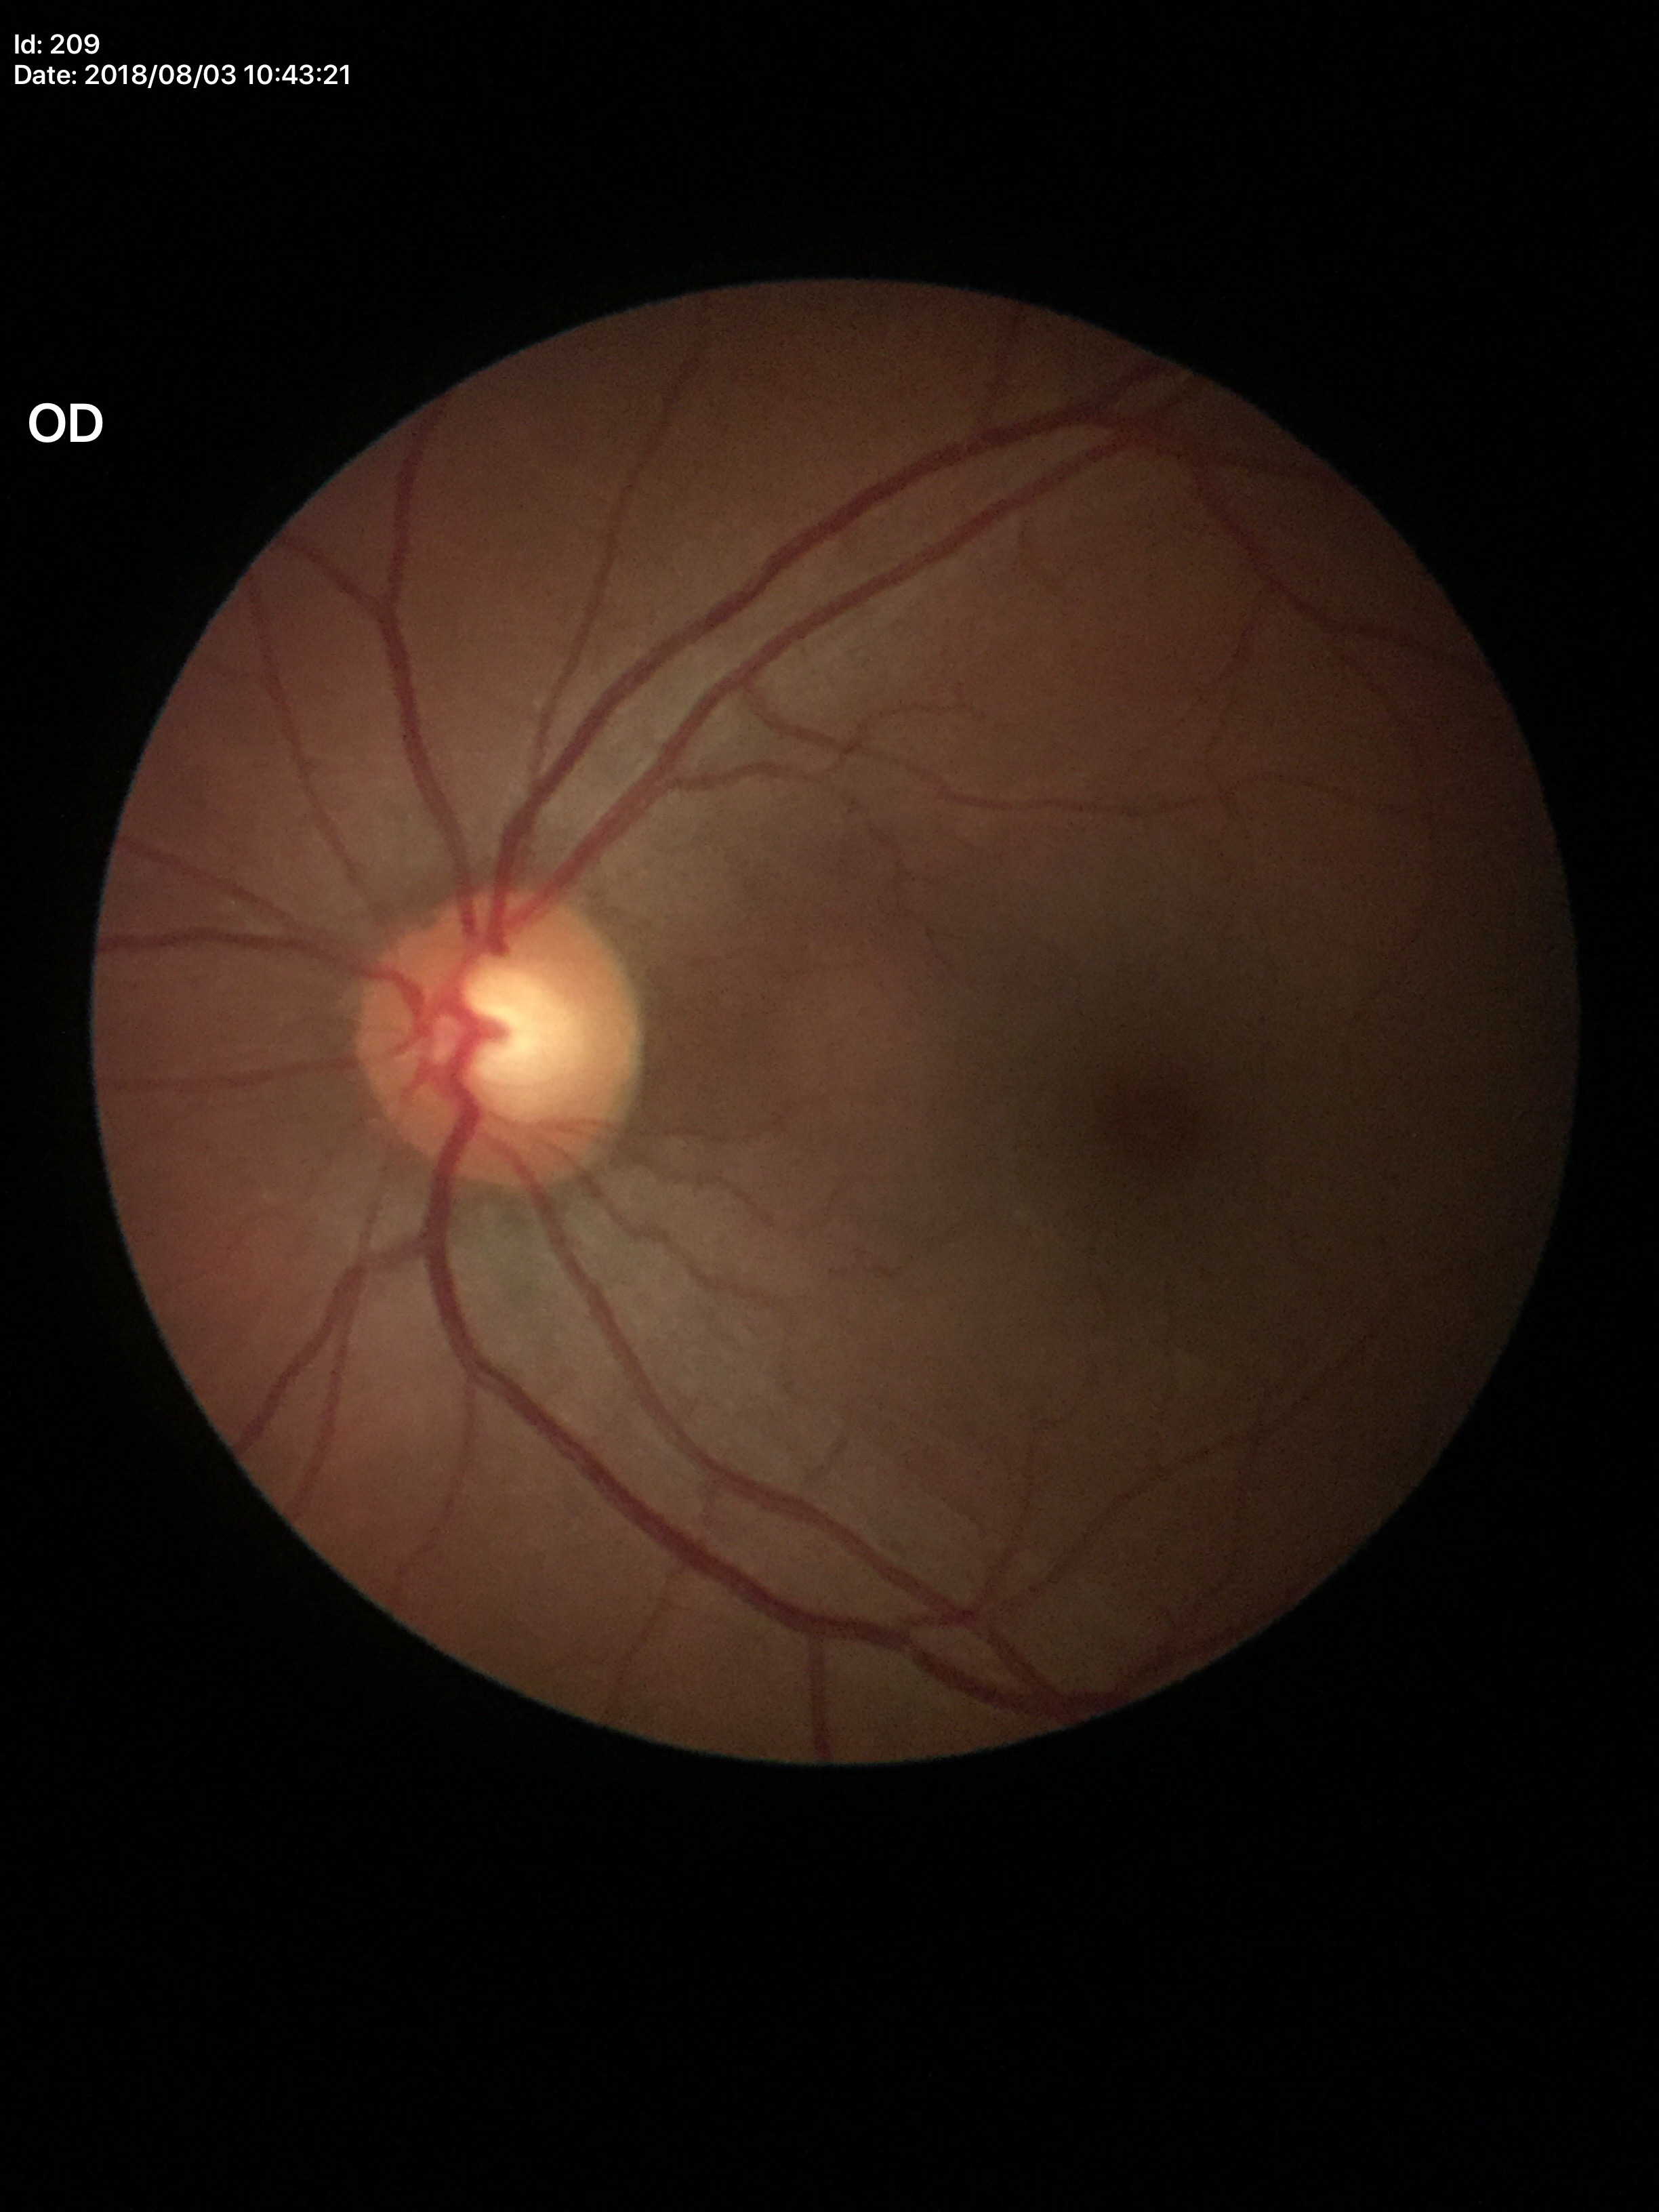
Glaucoma evaluation: negative (one of five ophthalmologists flagged glaucoma suspect). Vertical C/D ratio: 0.58. Horizontal CDR: 0.56.